45° field of view: 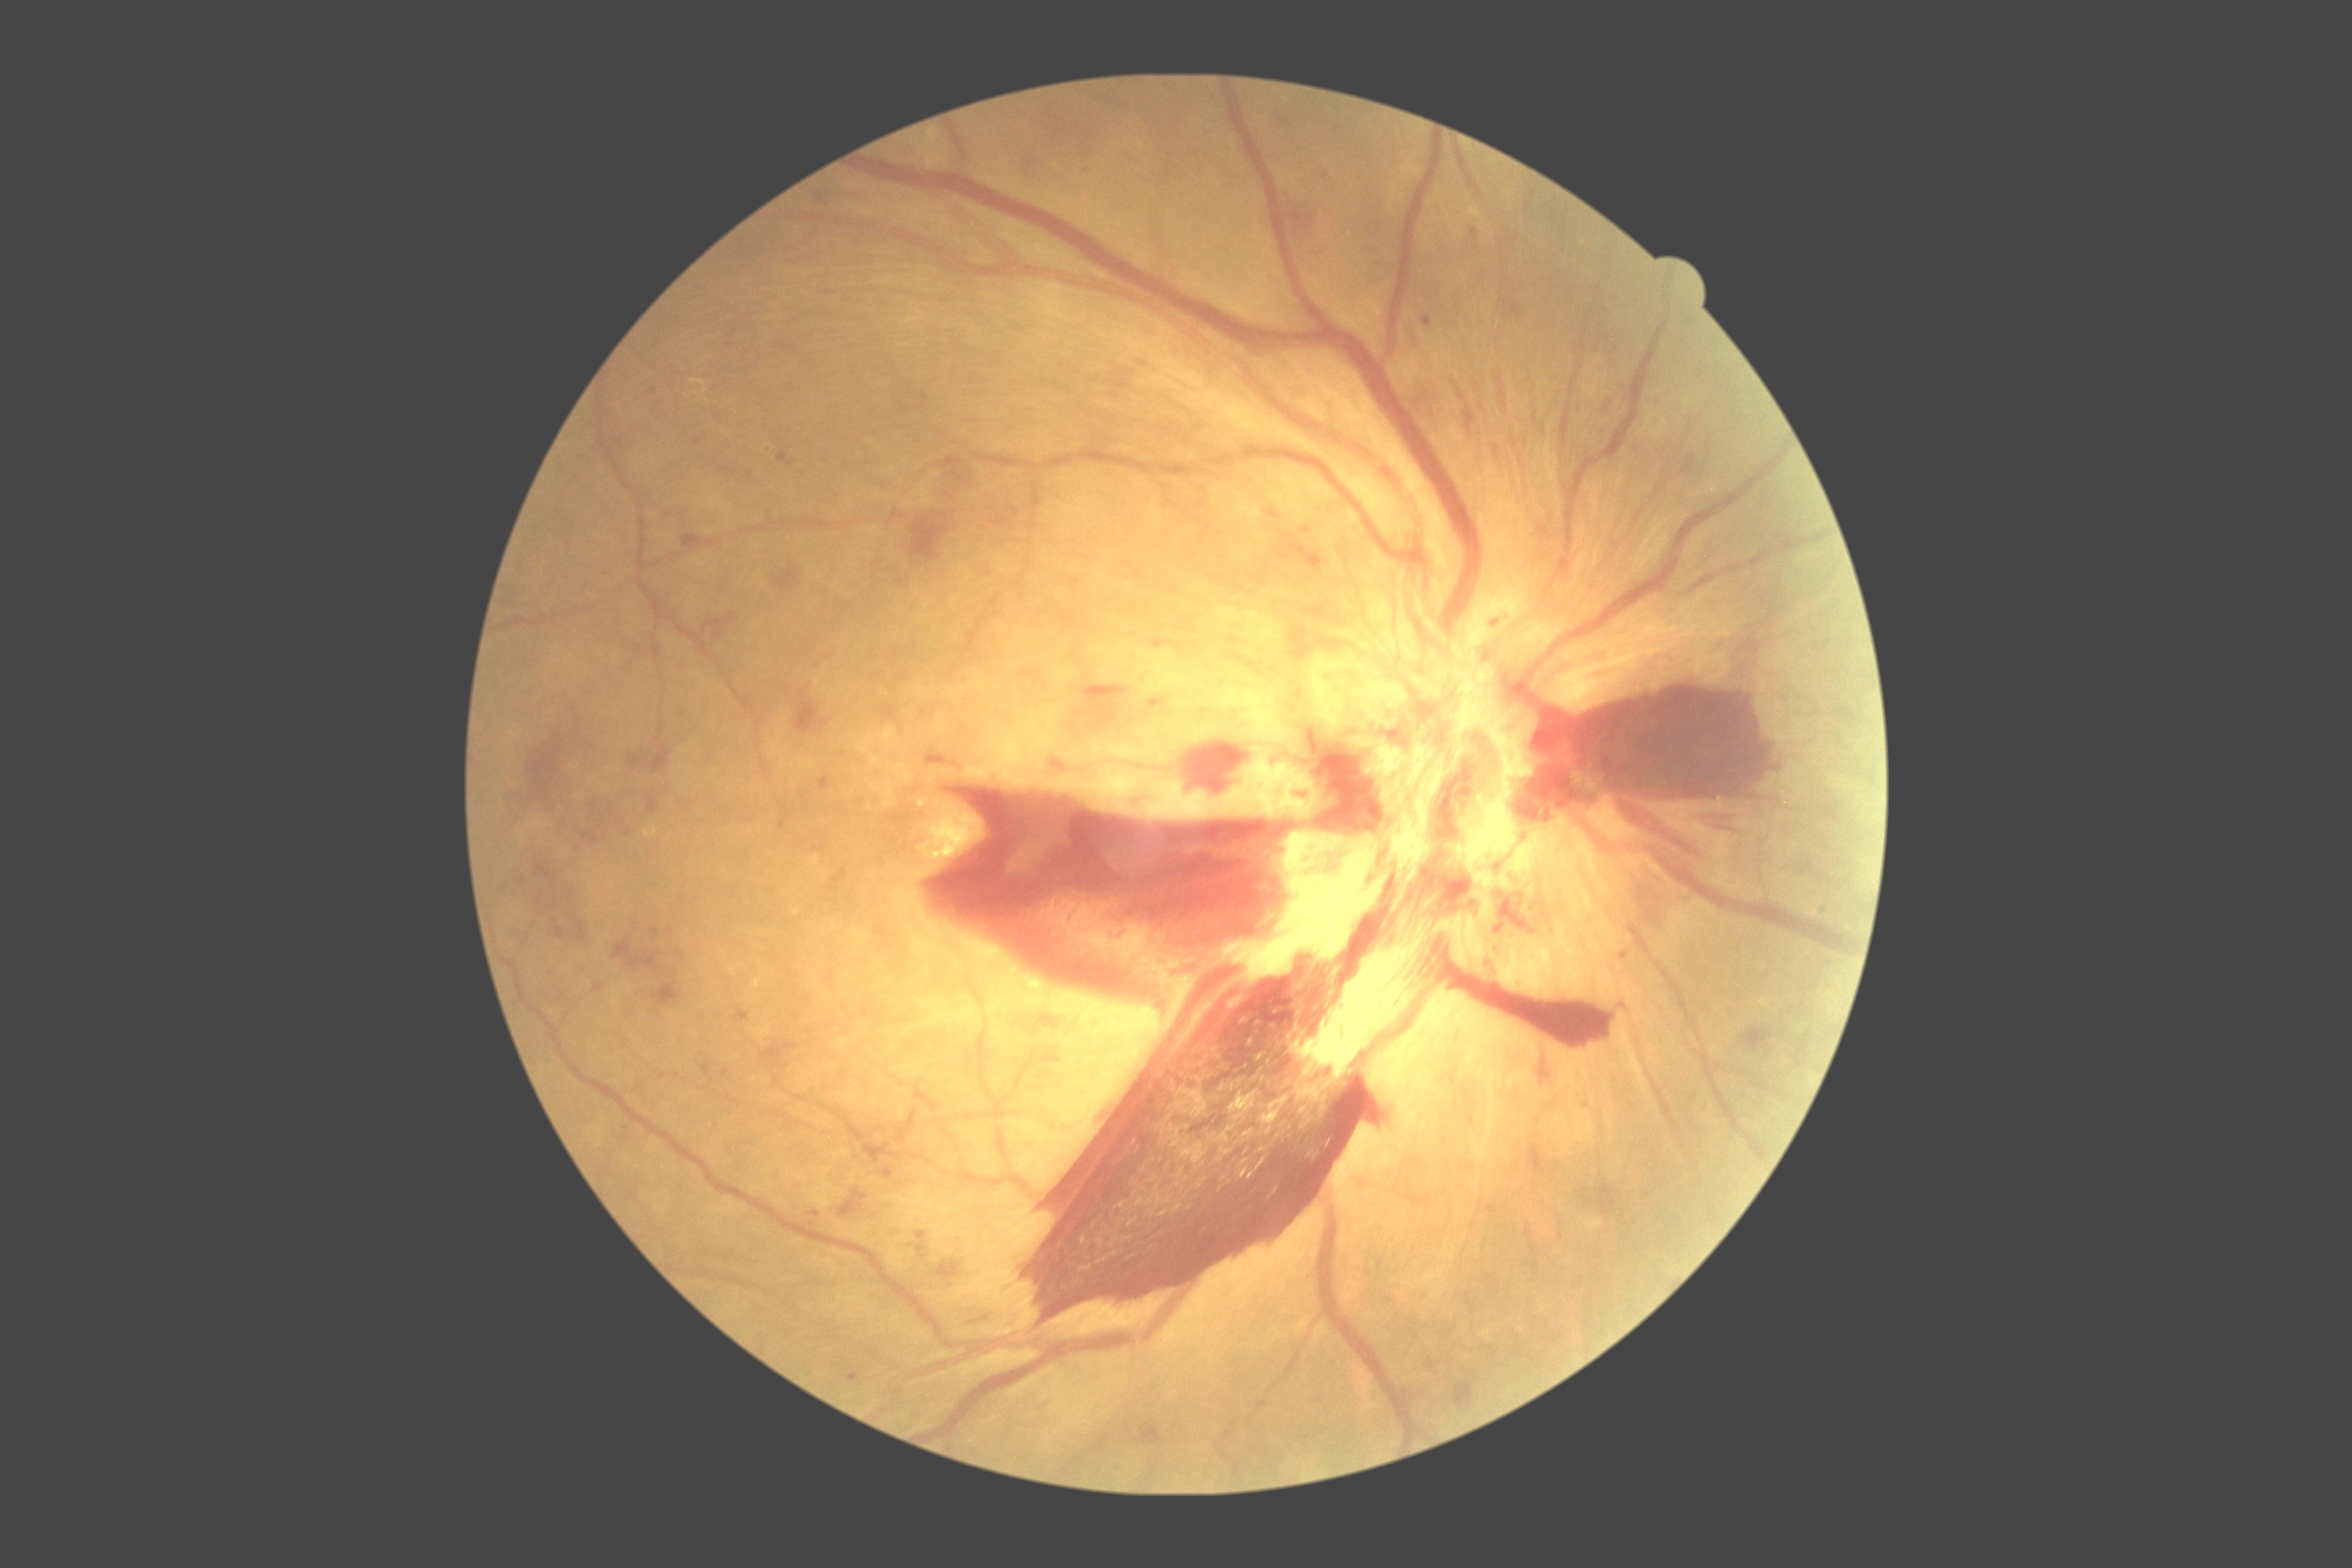

Diabetic retinopathy severity: 4/4 — neovascularization and/or vitreous/pre-retinal hemorrhage.